Camera: Natus RetCam Envision (130° FOV); infant wide-field fundus photograph:
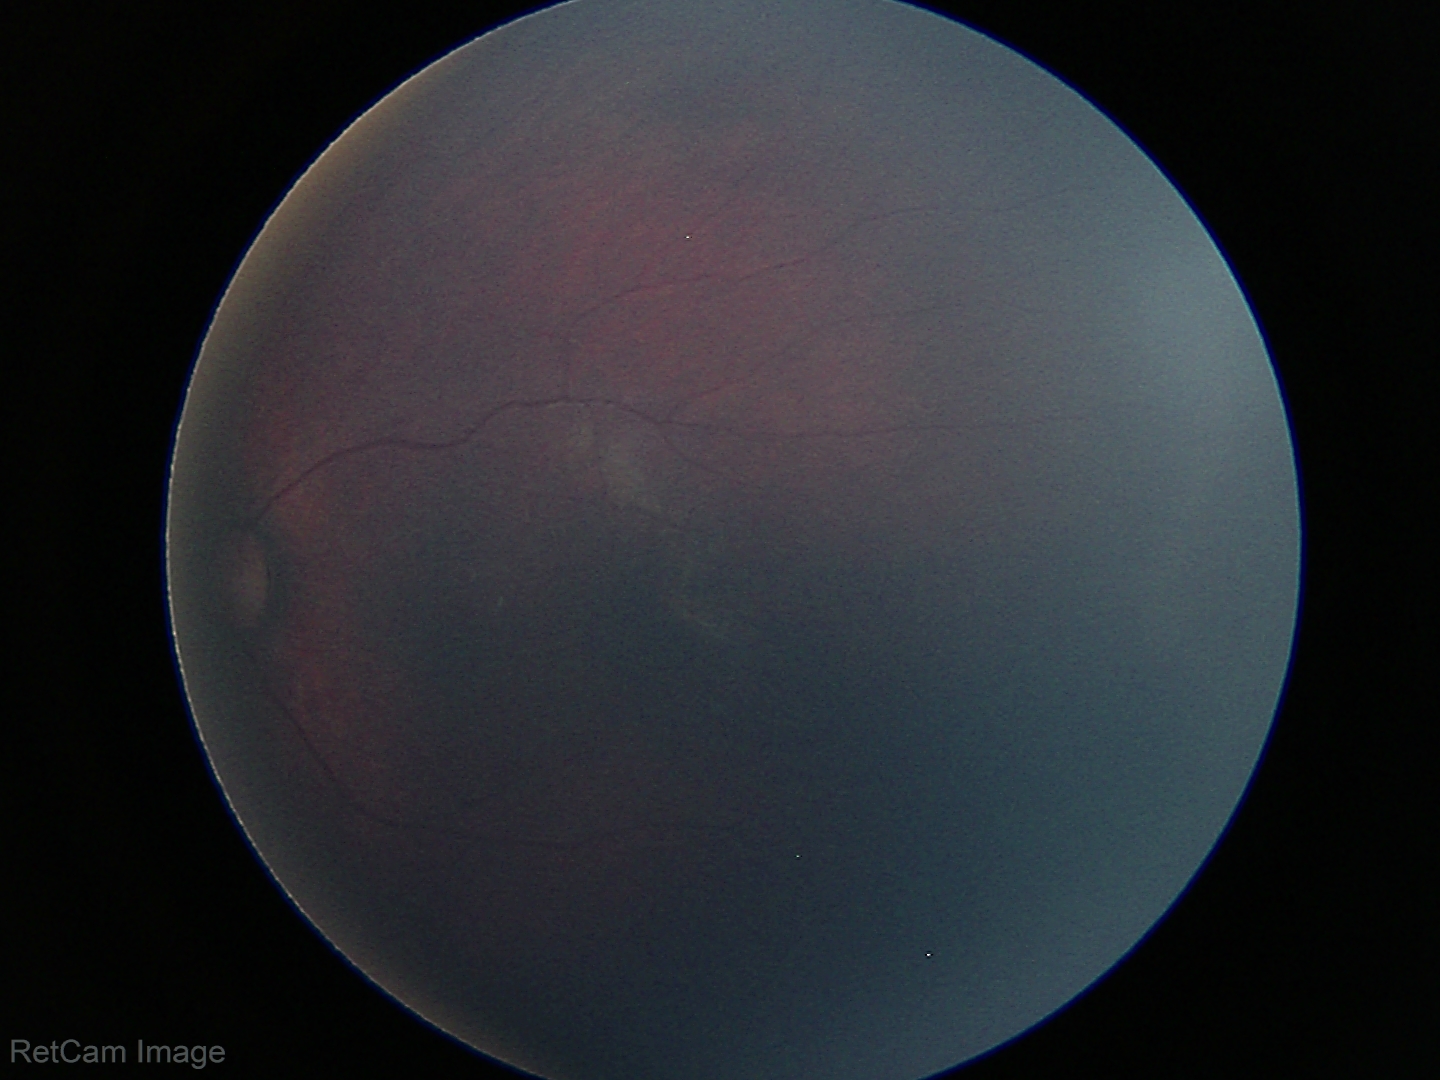

Physiological retinal appearance for postconceptual age.